CFP; 45° FOV; 2352 by 1568 pixels — 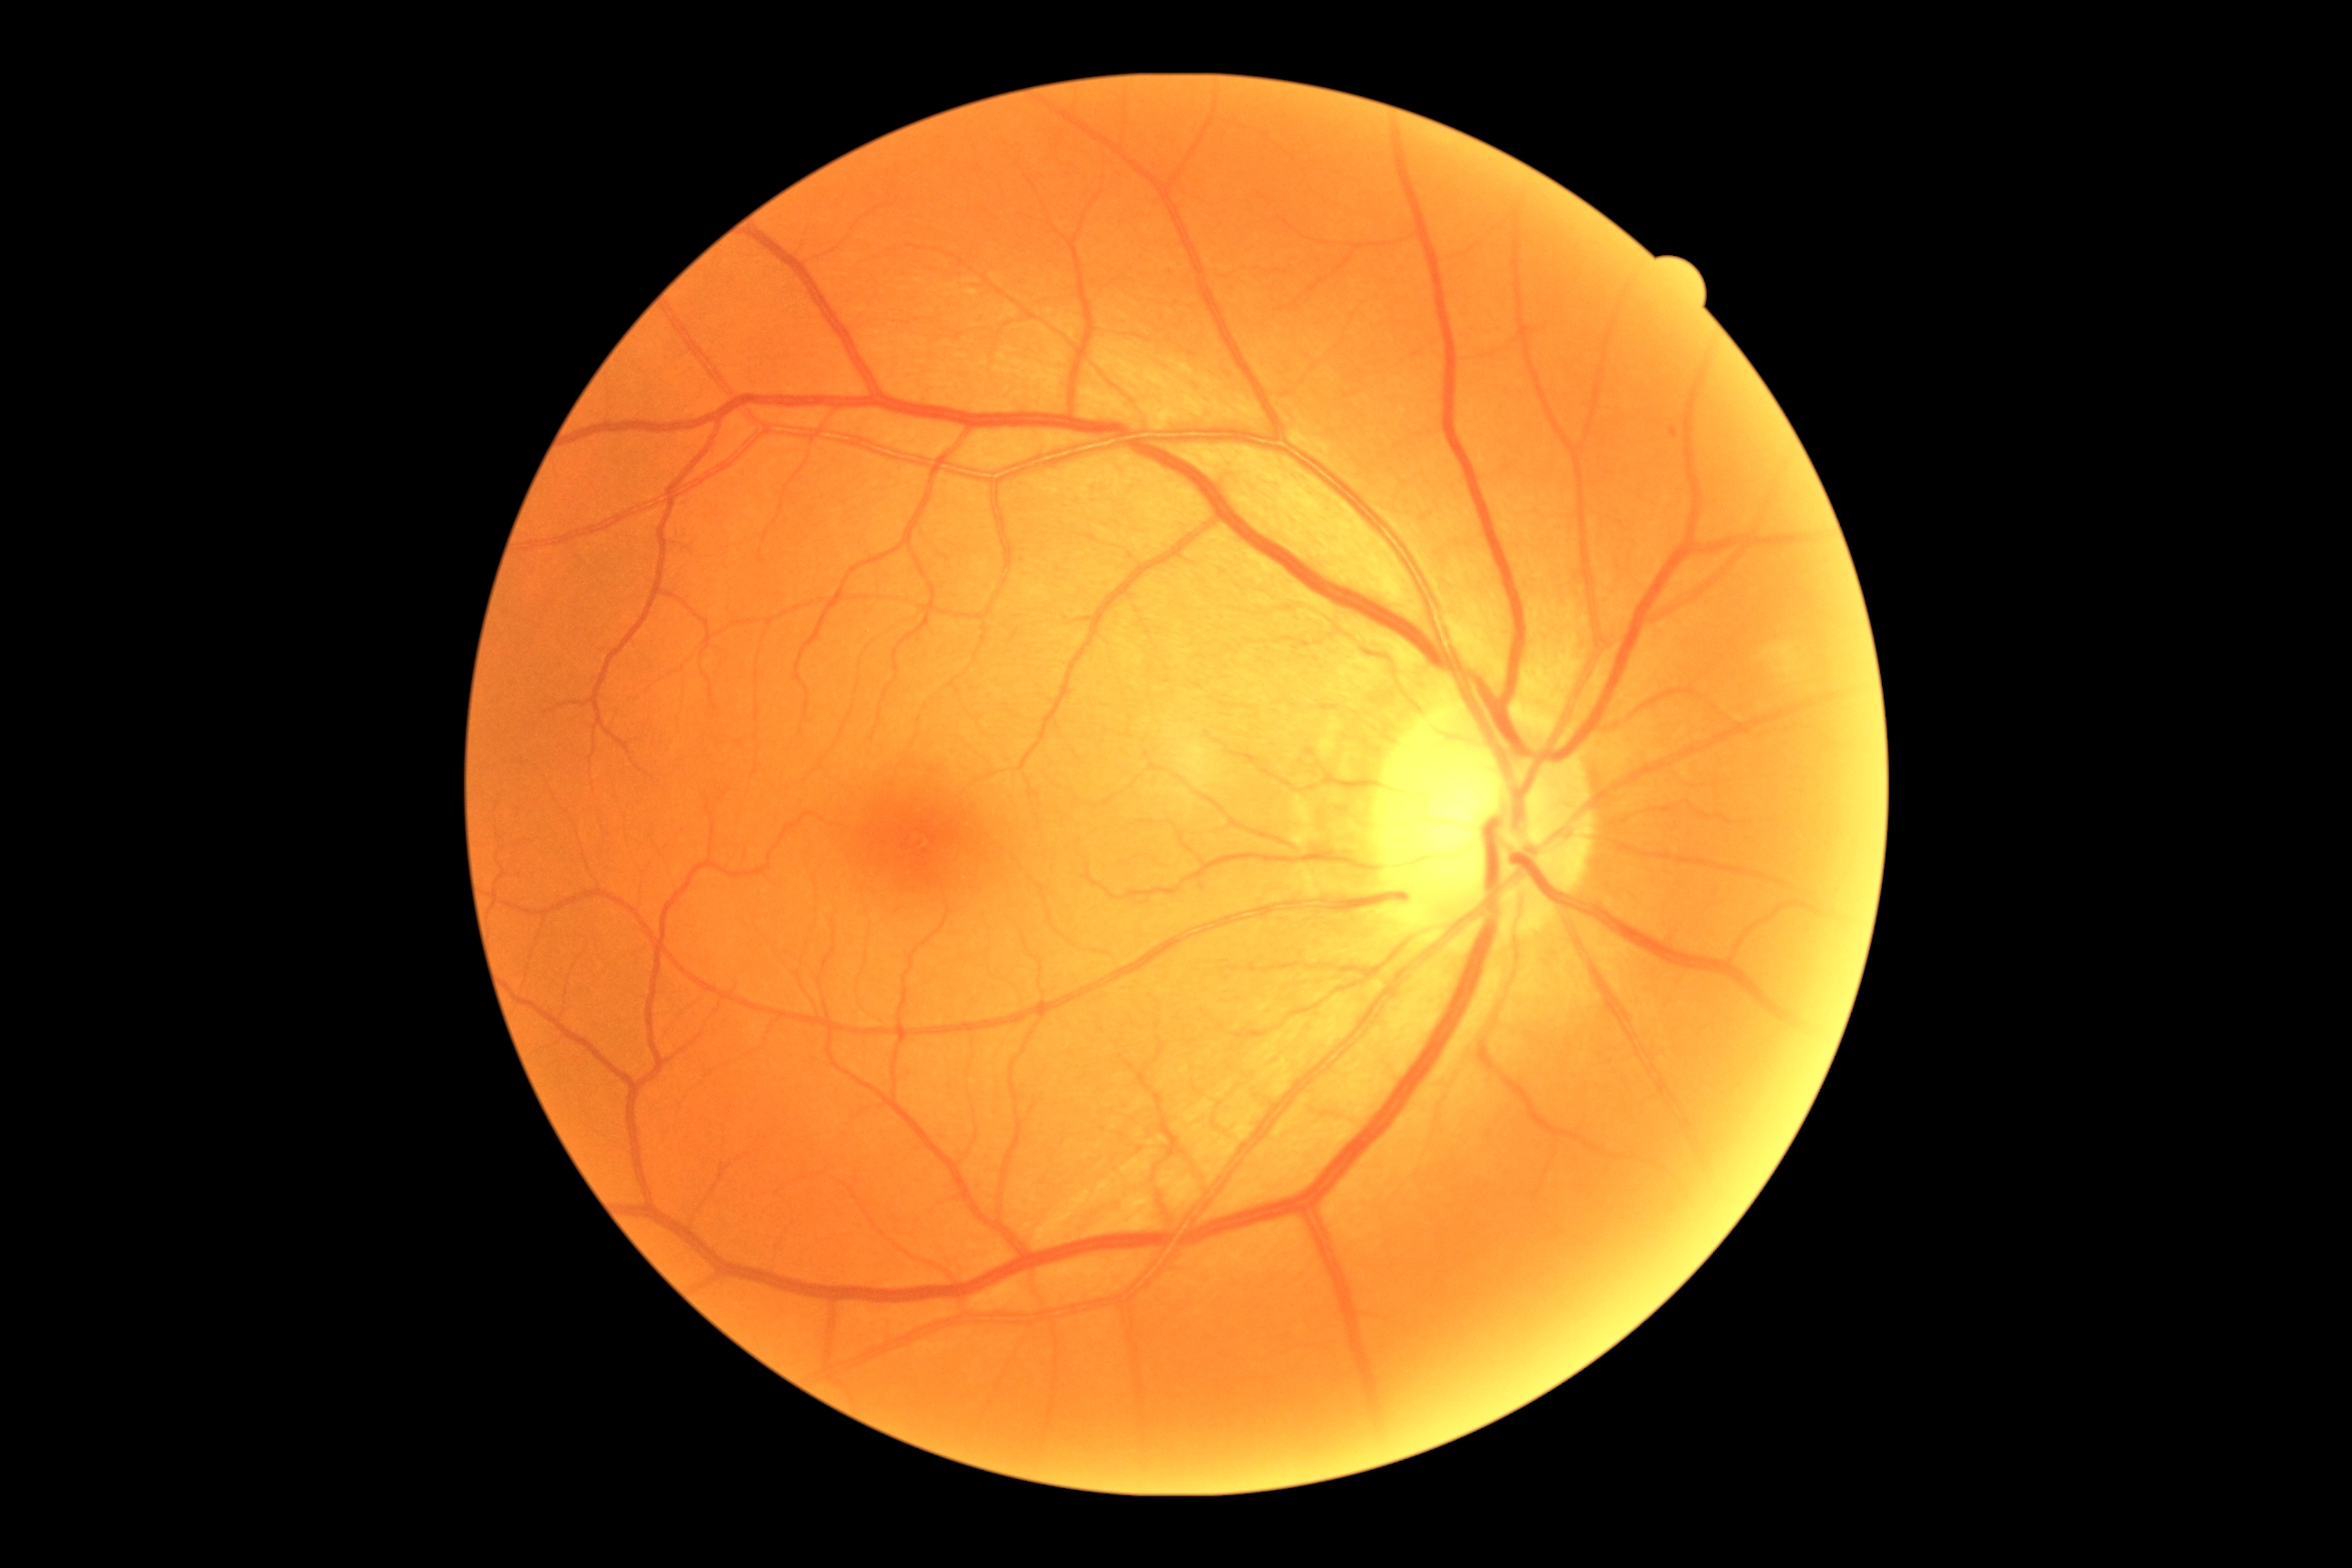 Diabetic retinopathy (DR): 2/4.